45° field of view: 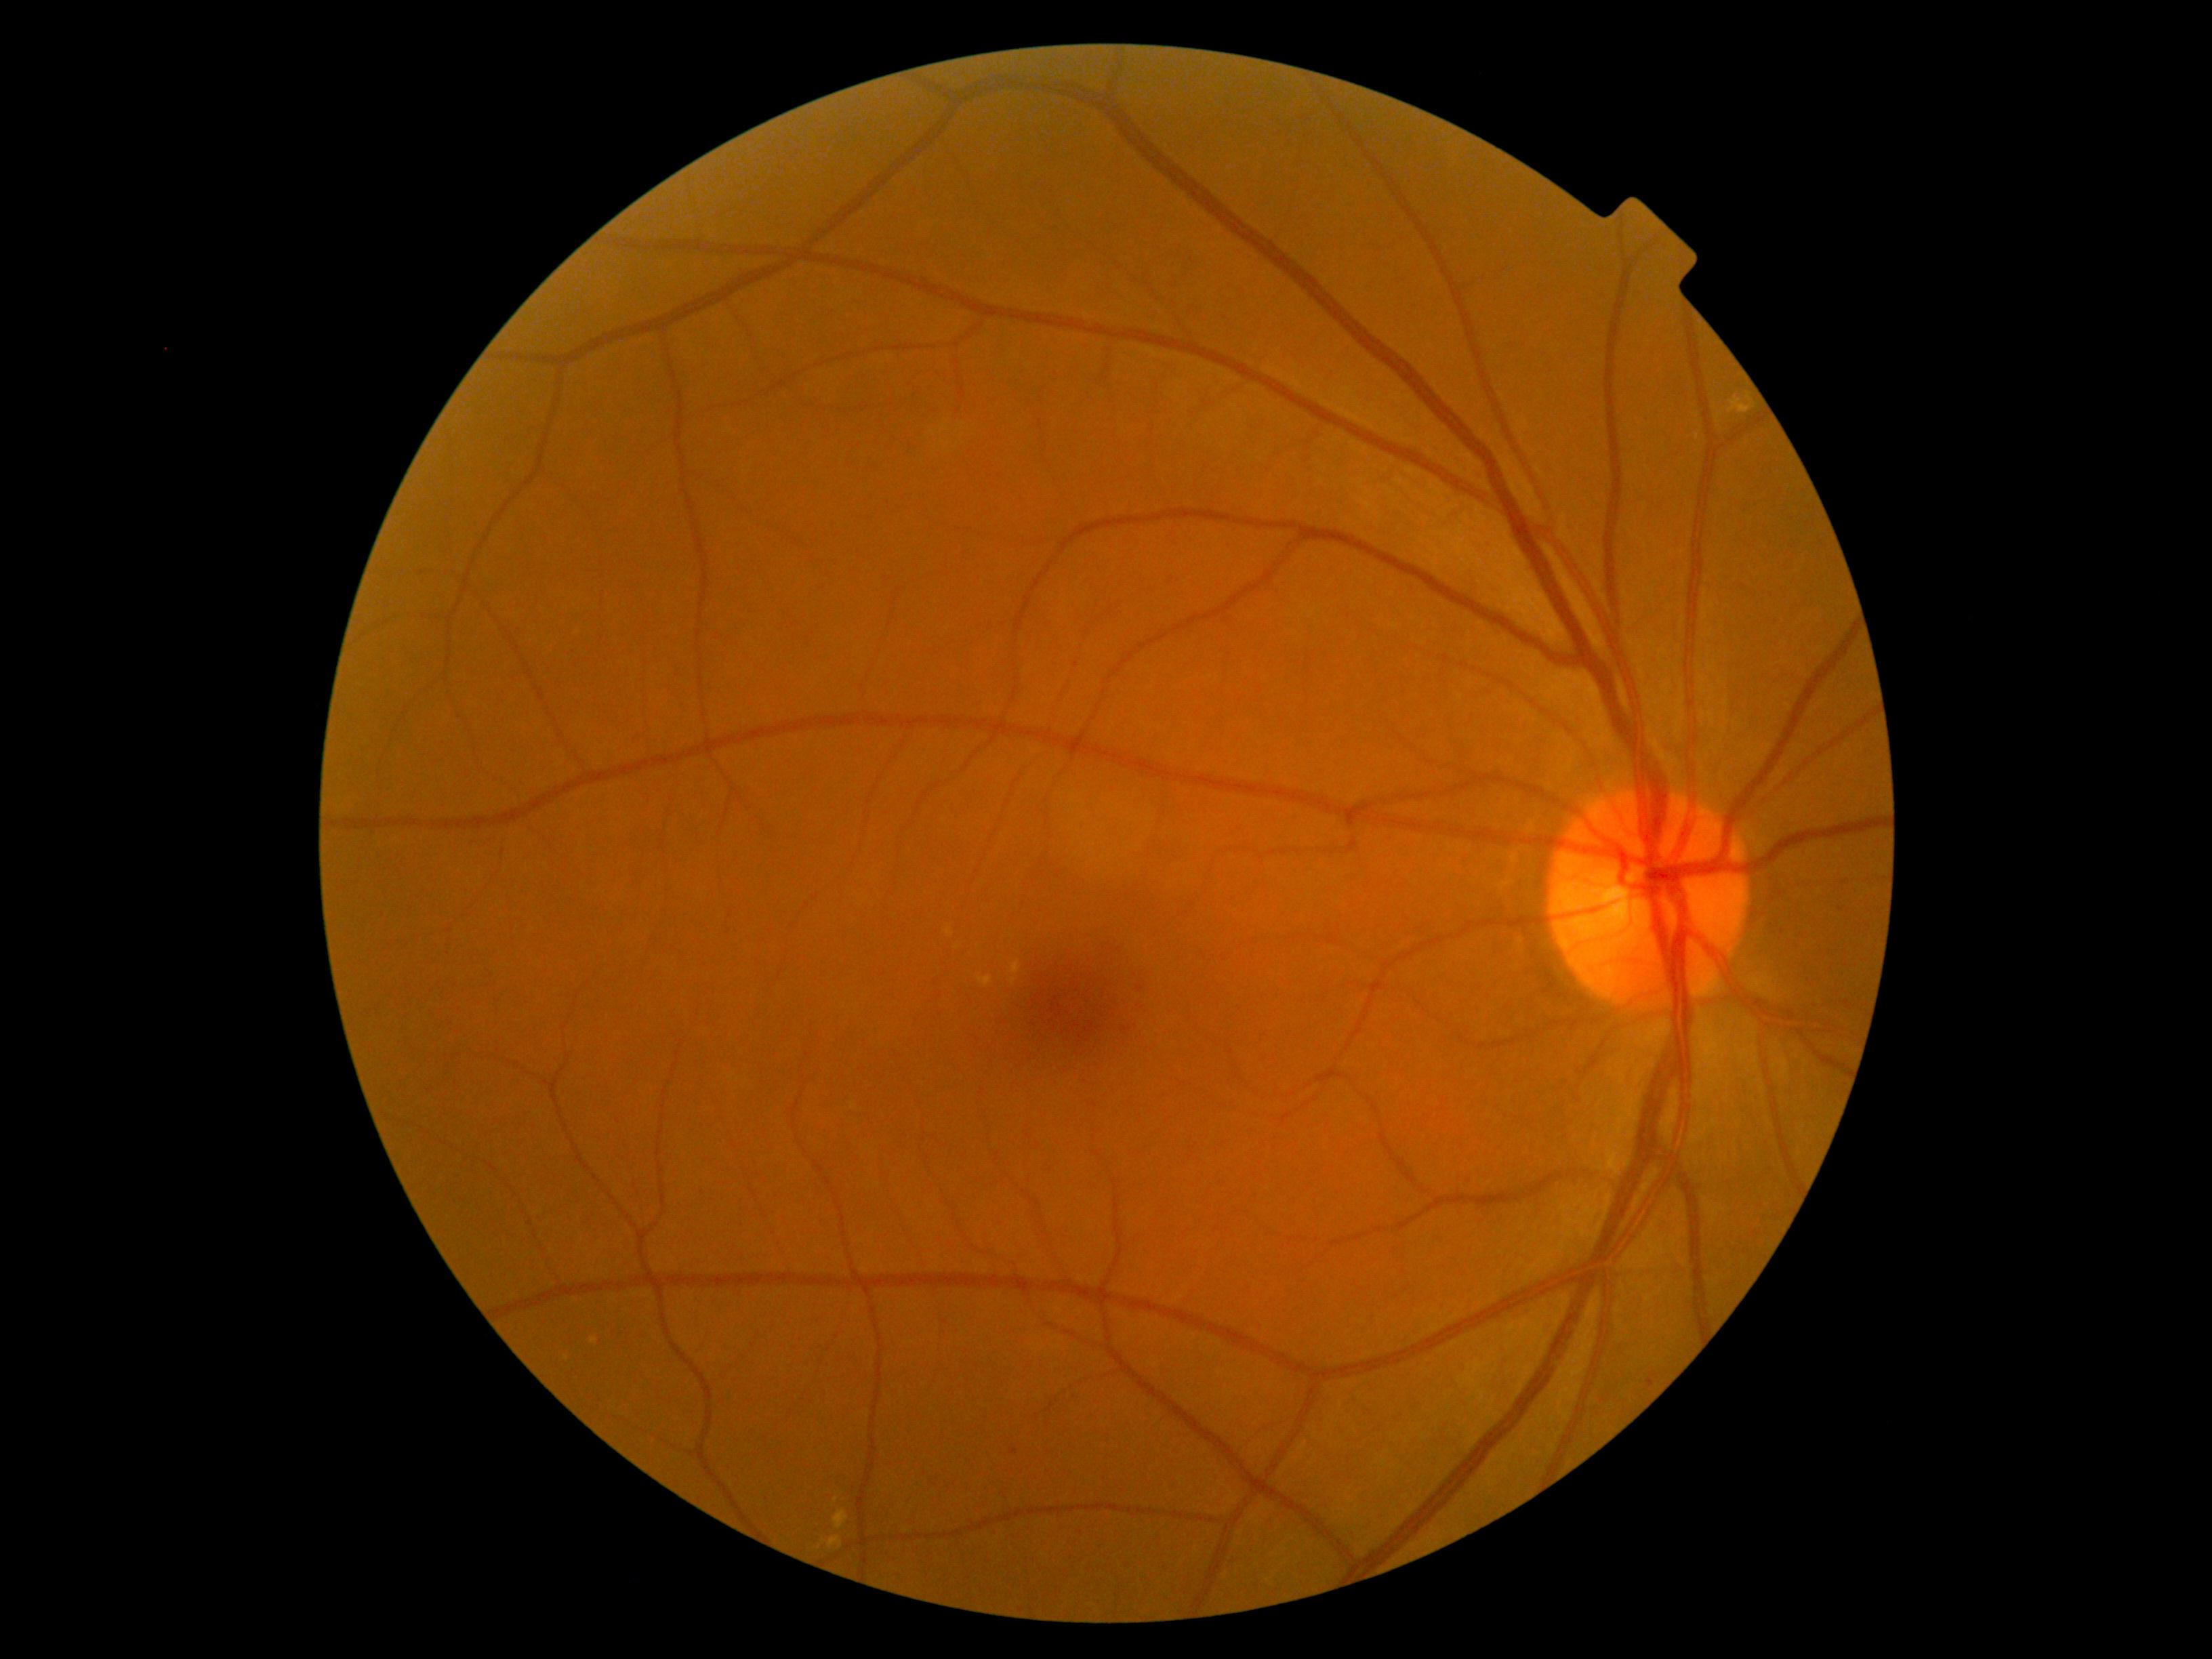

DR stage is grade 2 (moderate NPDR).